45° field of view. NIDEK AFC-230 fundus camera: 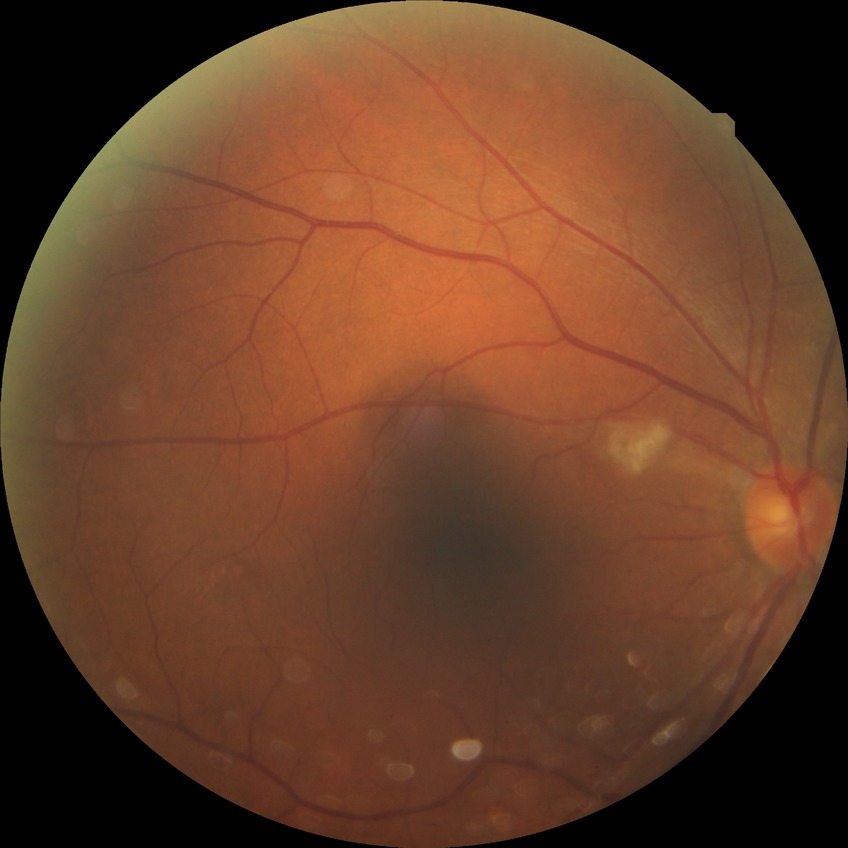
Modified Davis classification: no diabetic retinopathy.